Pediatric wide-field fundus photograph; acquired on the Clarity RetCam 3; 640x480px:
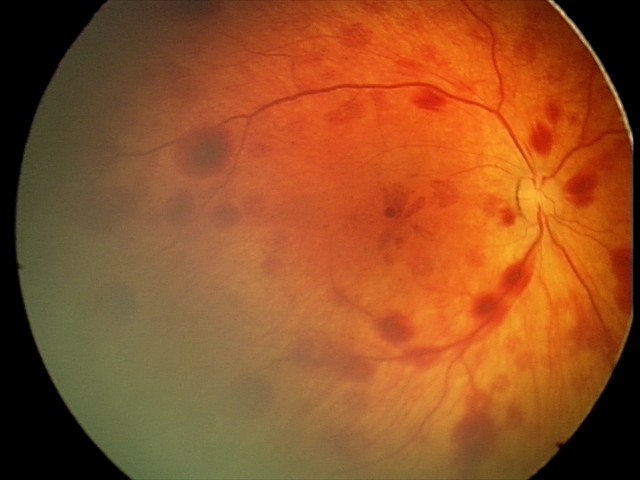

Q: What is the screening diagnosis?
A: retinal hemorrhages